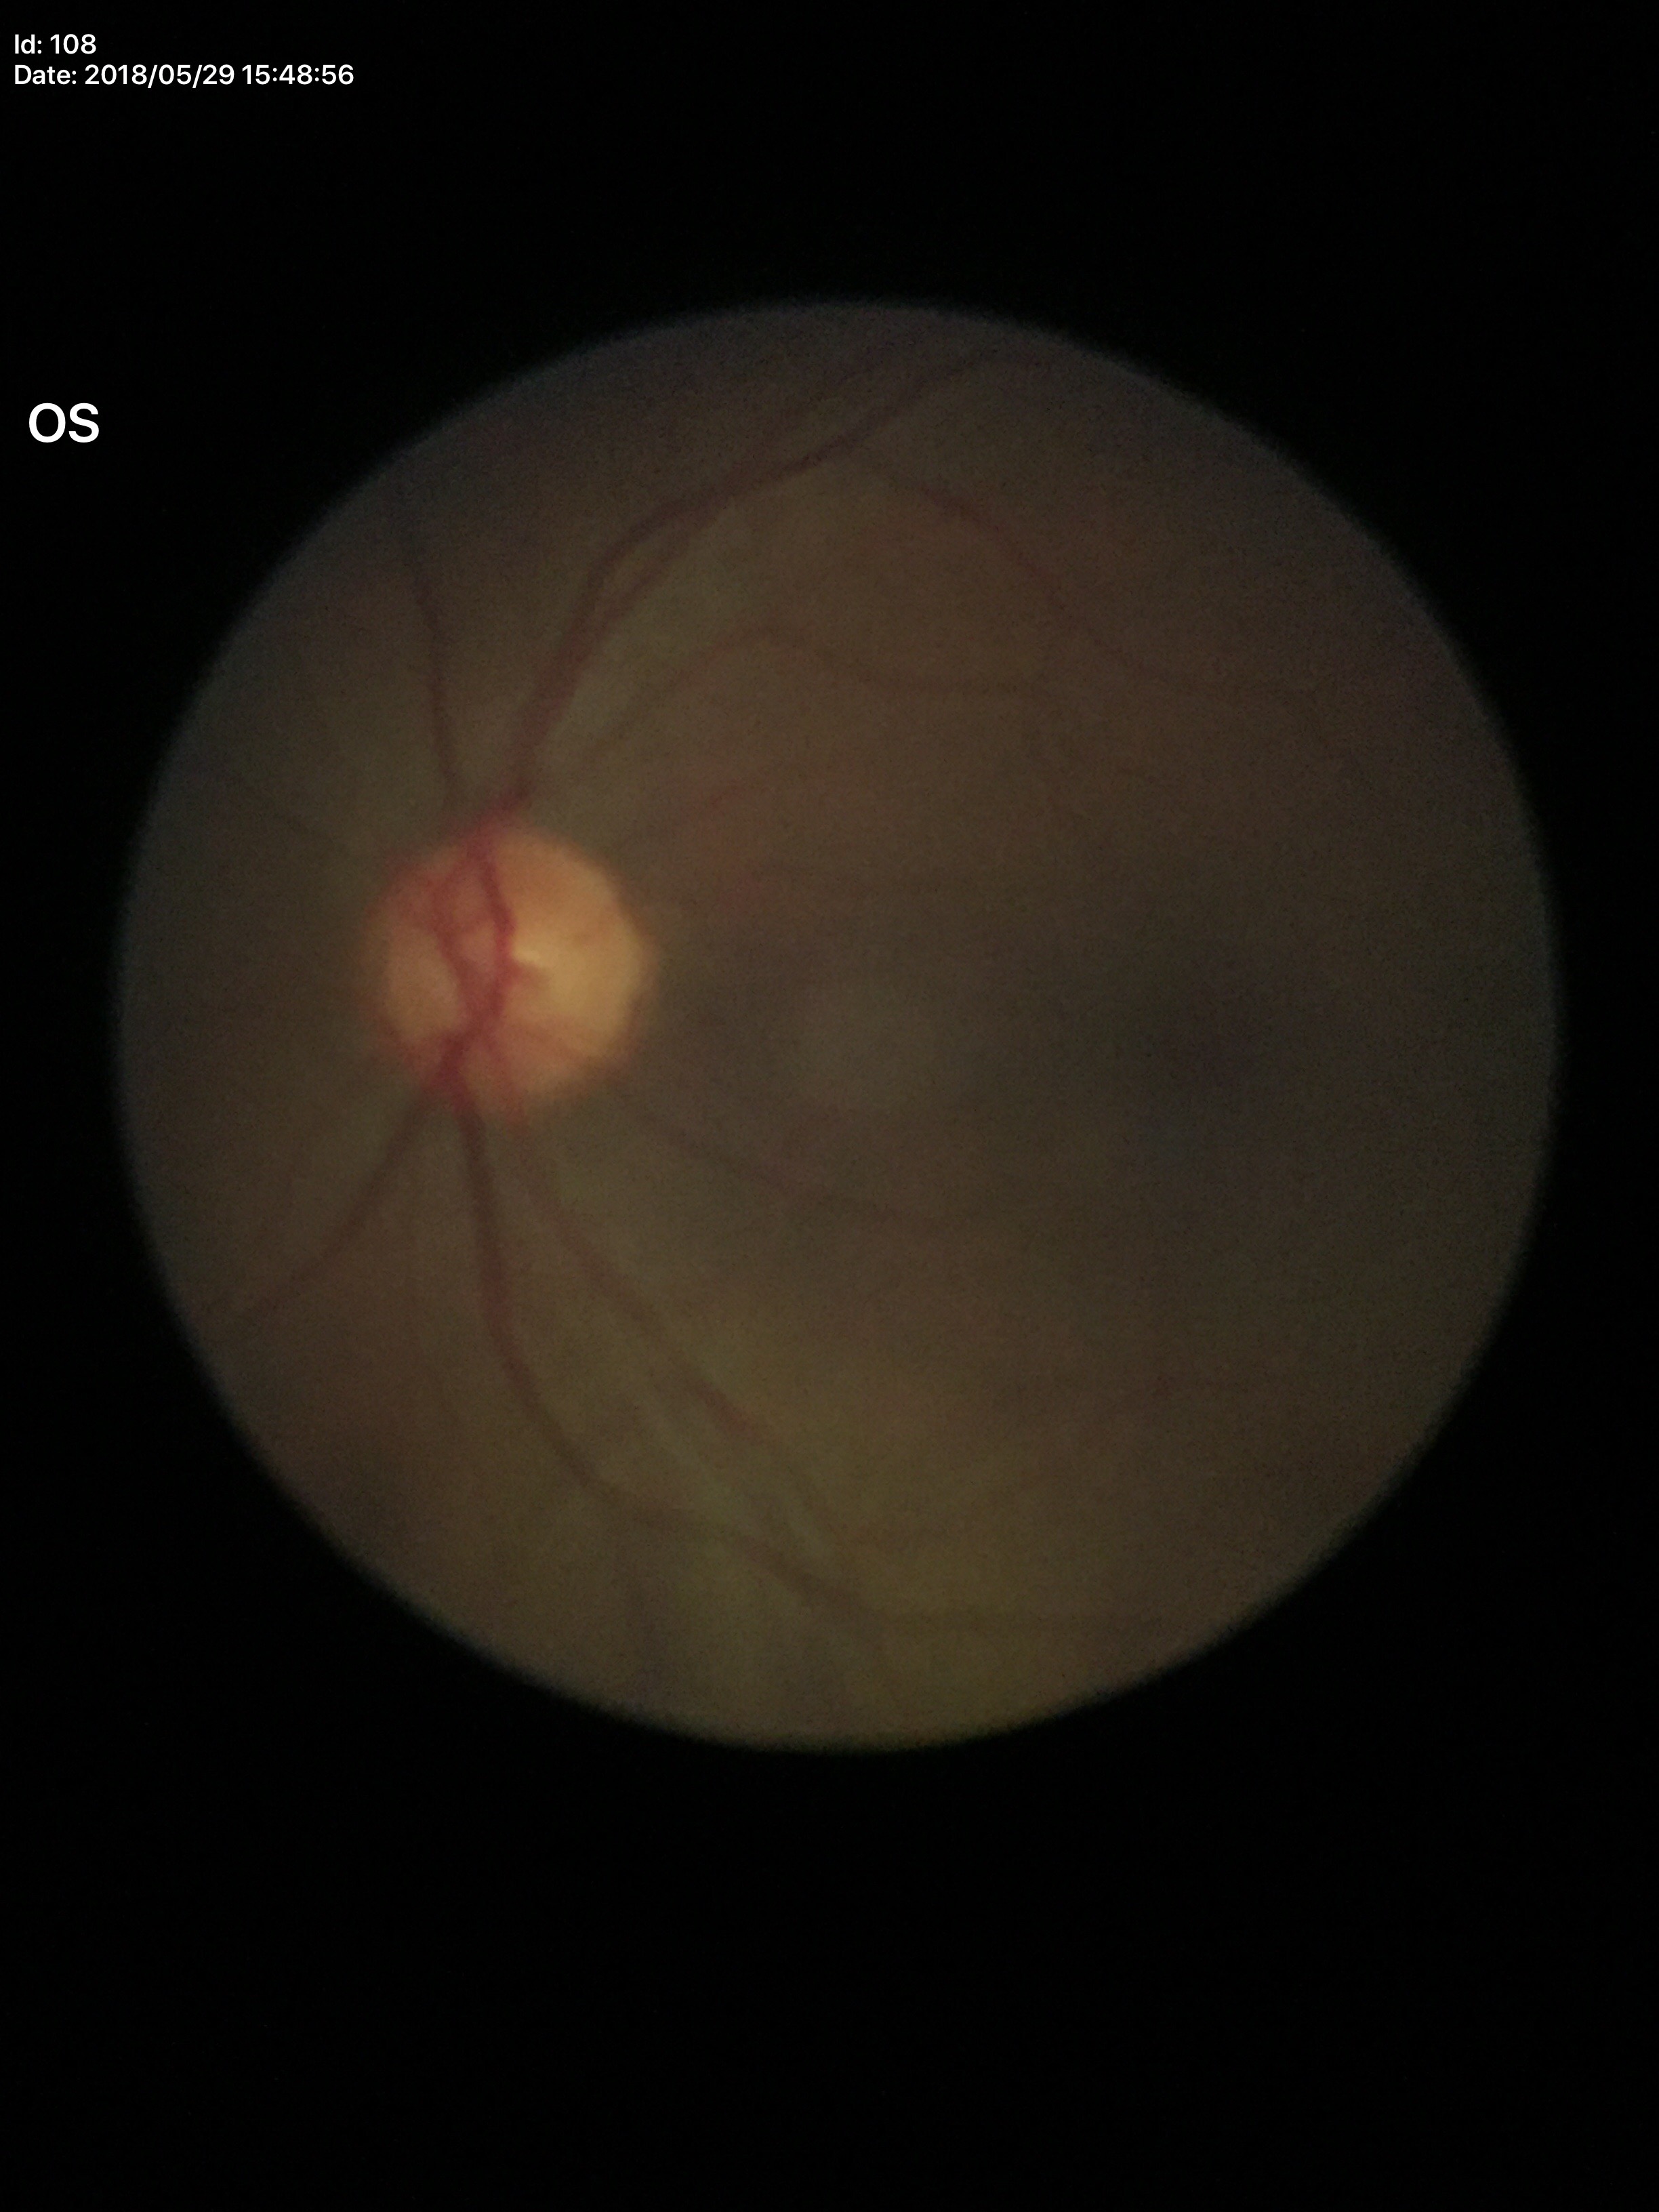 Glaucoma assessment=no suspicious findings; vertical CDR=0.49; horizontal CDR=0.55; area cup-disc ratio=0.27